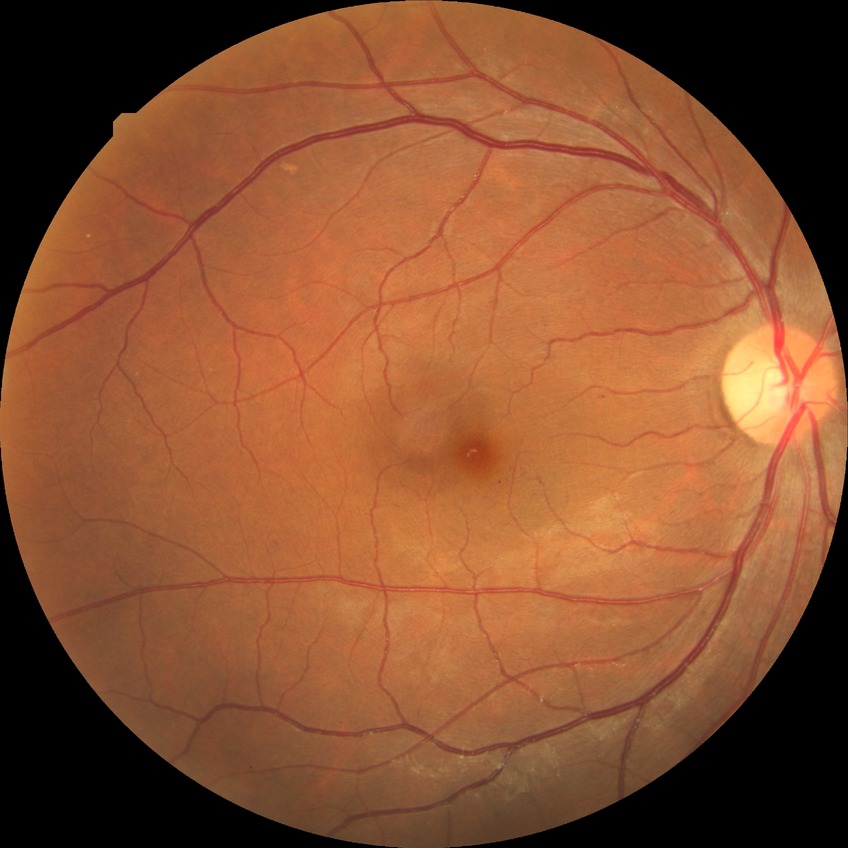
Retinopathy grade is simple diabetic retinopathy.